Acquired with a NIDEK AFC-230; posterior pole photograph; 848 by 848 pixels.
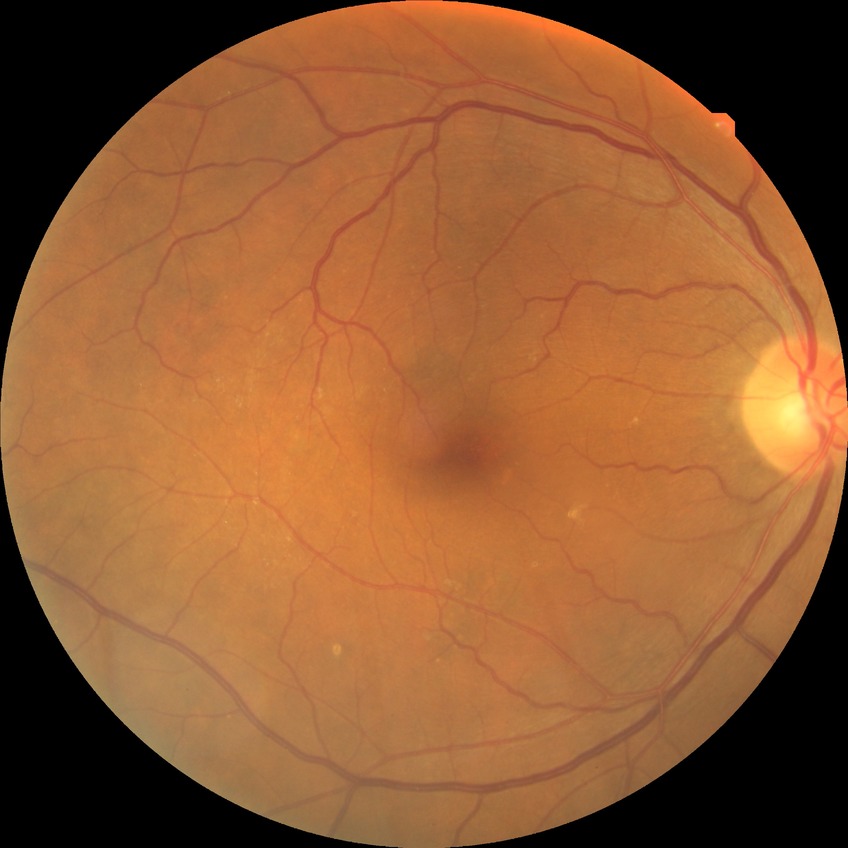
- retinopathy grade — simple diabetic retinopathy